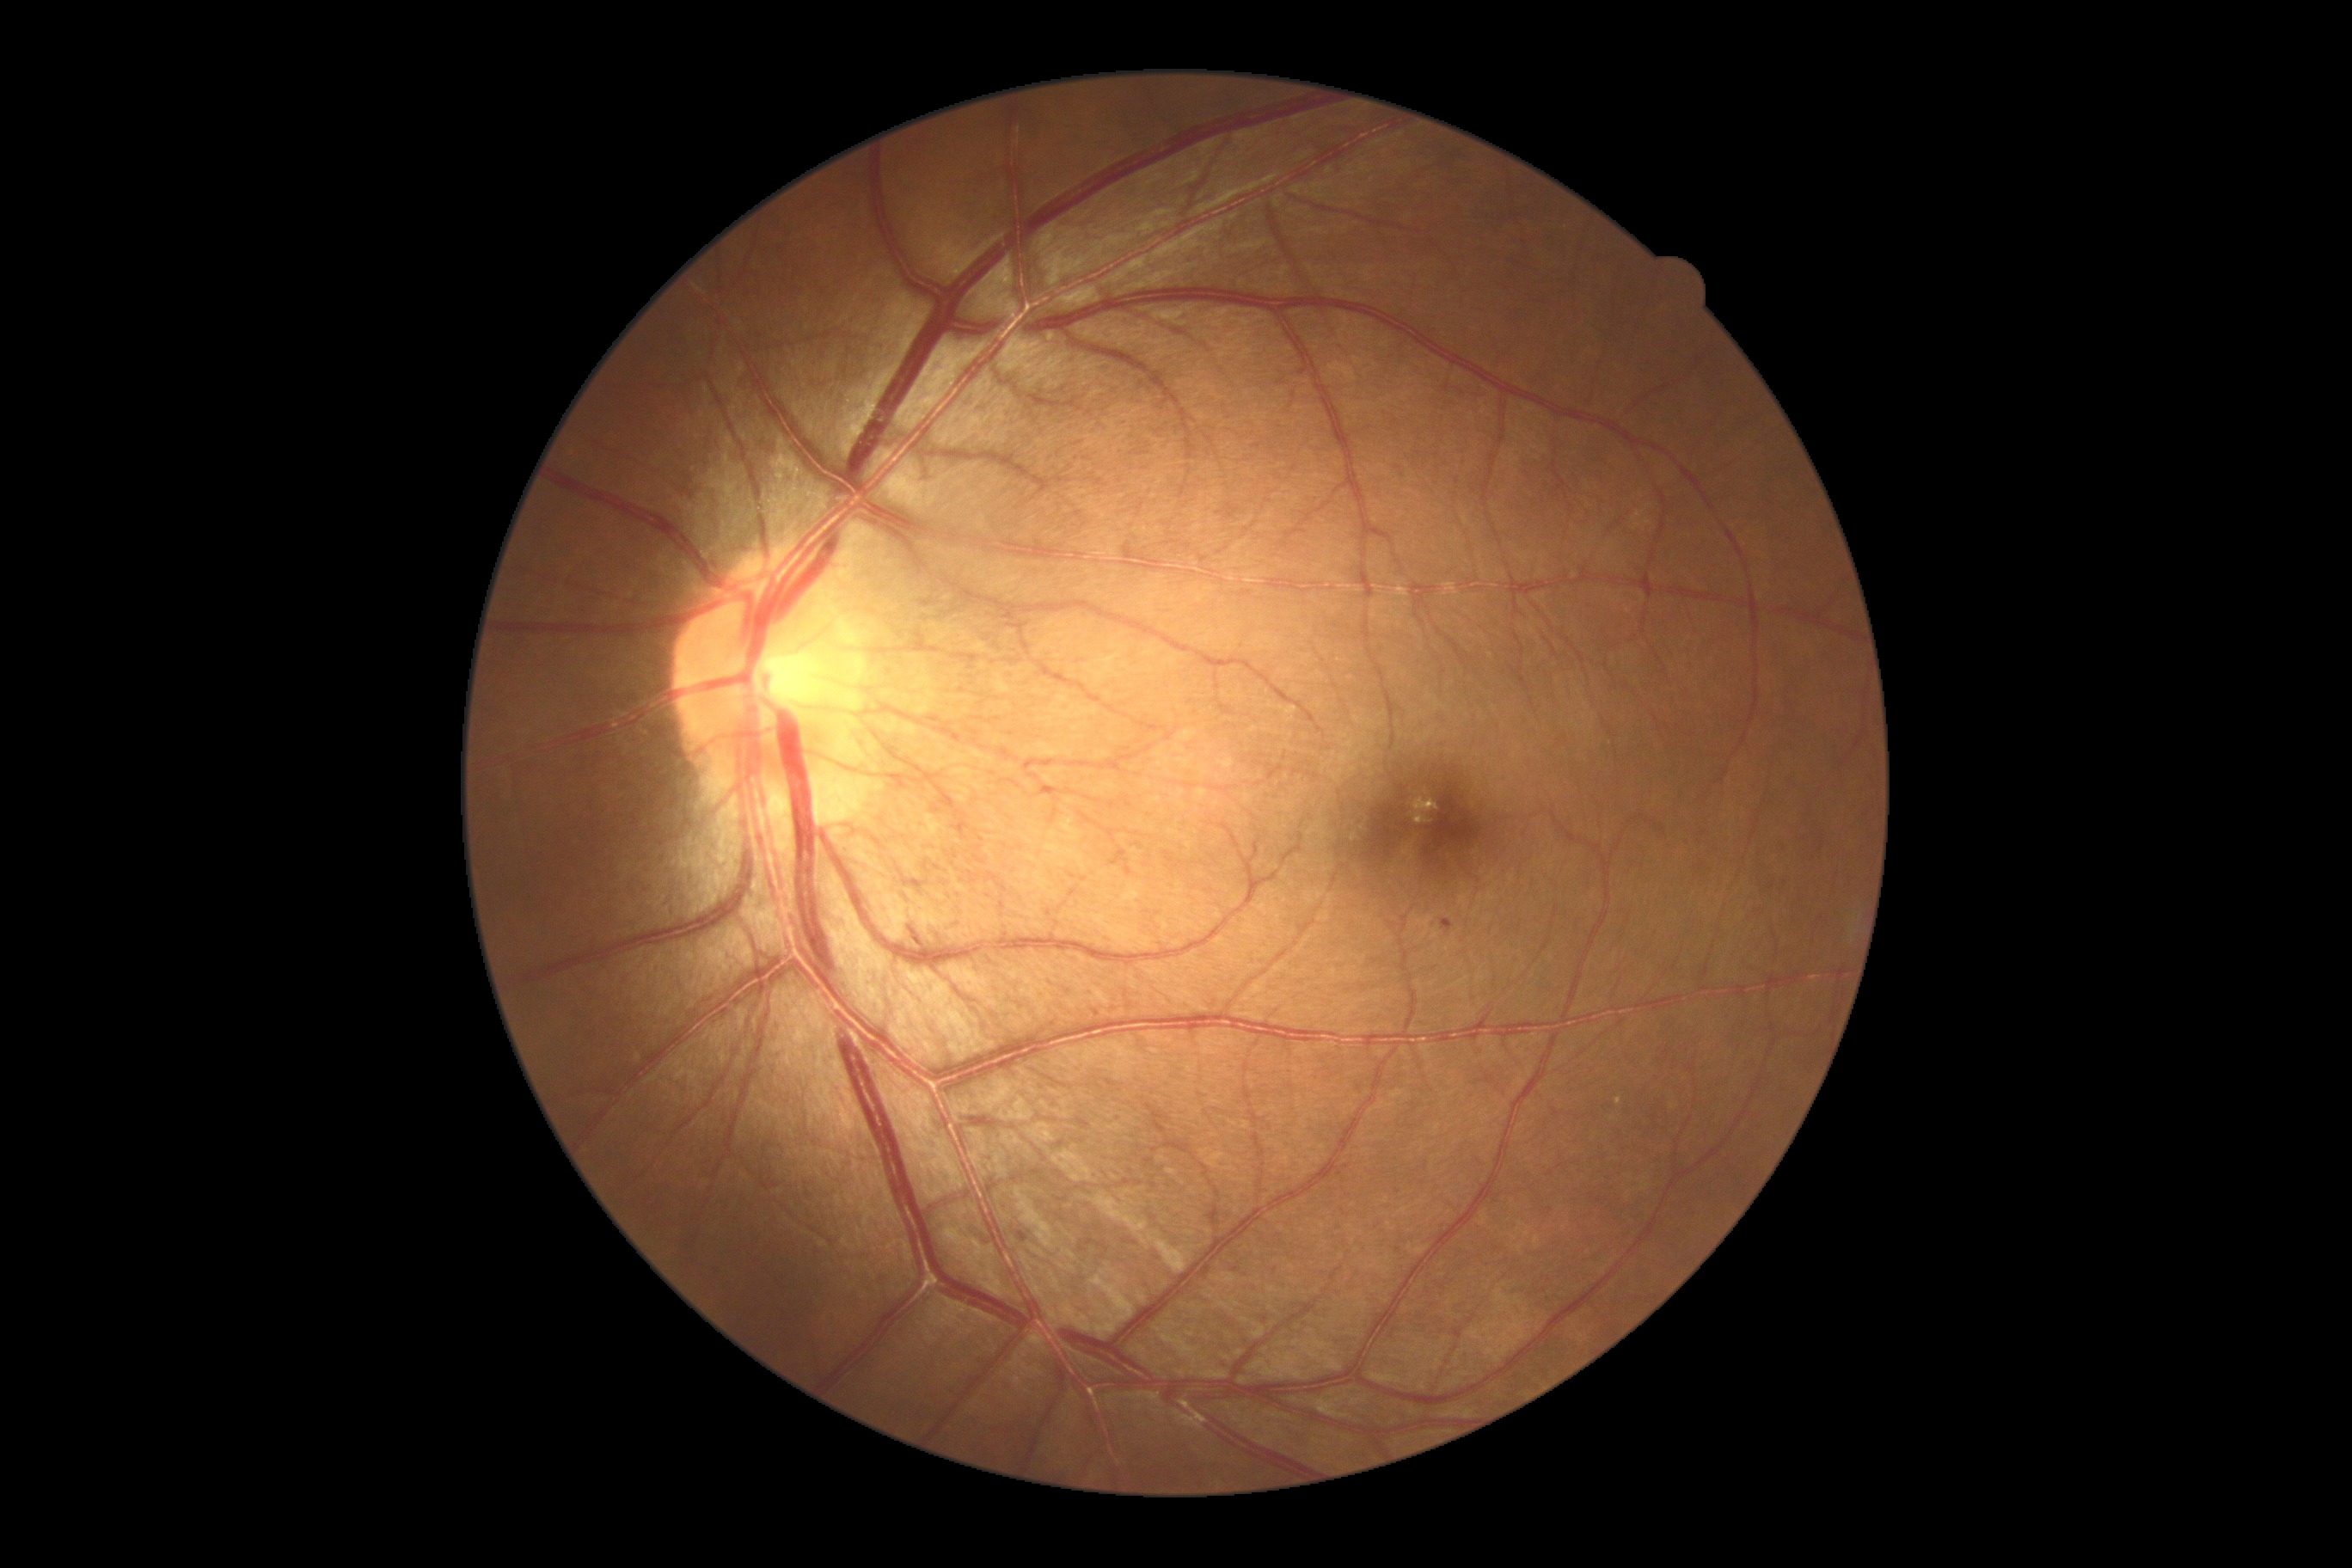

<lesions>
  <dr_grade>1</dr_grade>
  <he />
  <se />
  <ex />
  <ma>(left=1017, top=1232, right=1029, bottom=1244) | (left=1442, top=919, right=1454, bottom=931)</ma>
</lesions>